Color fundus photograph: 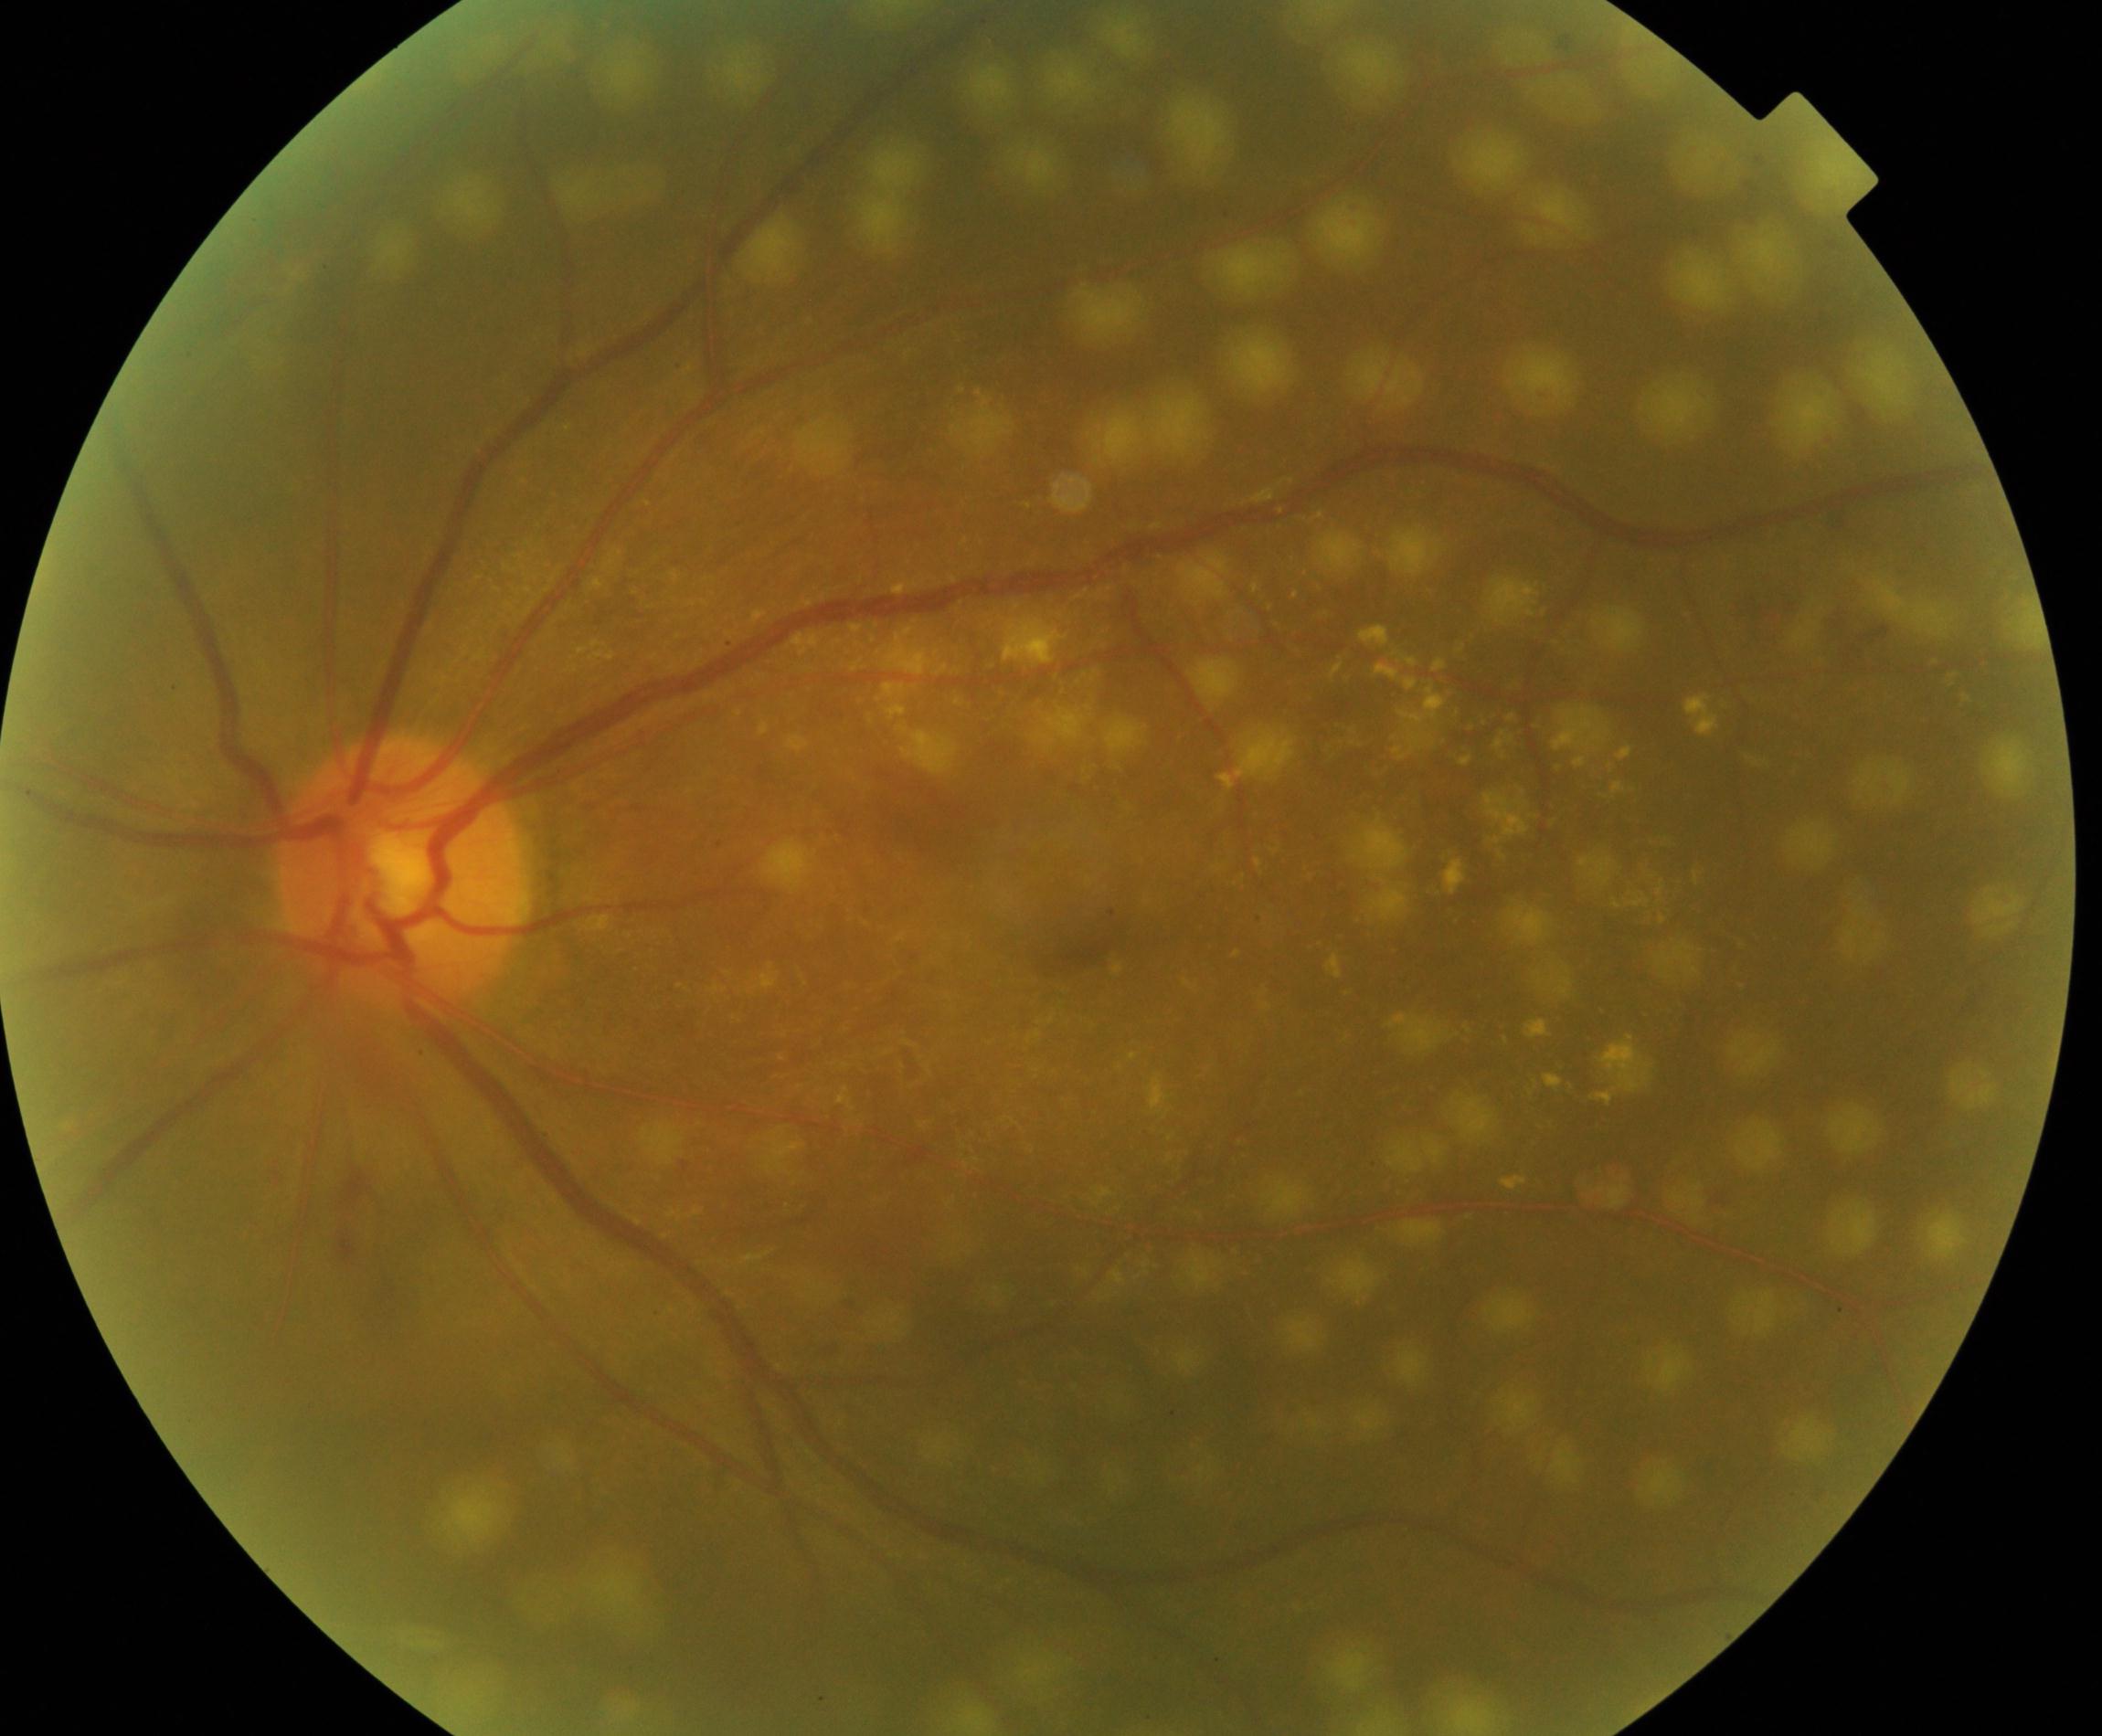
Treatment history: laser spots.